Camera: Nidek AFC-330:
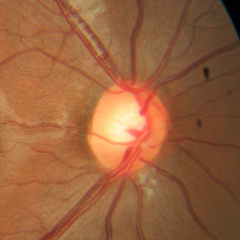 Optic nerve head appearance consistent with no signs of glaucoma.